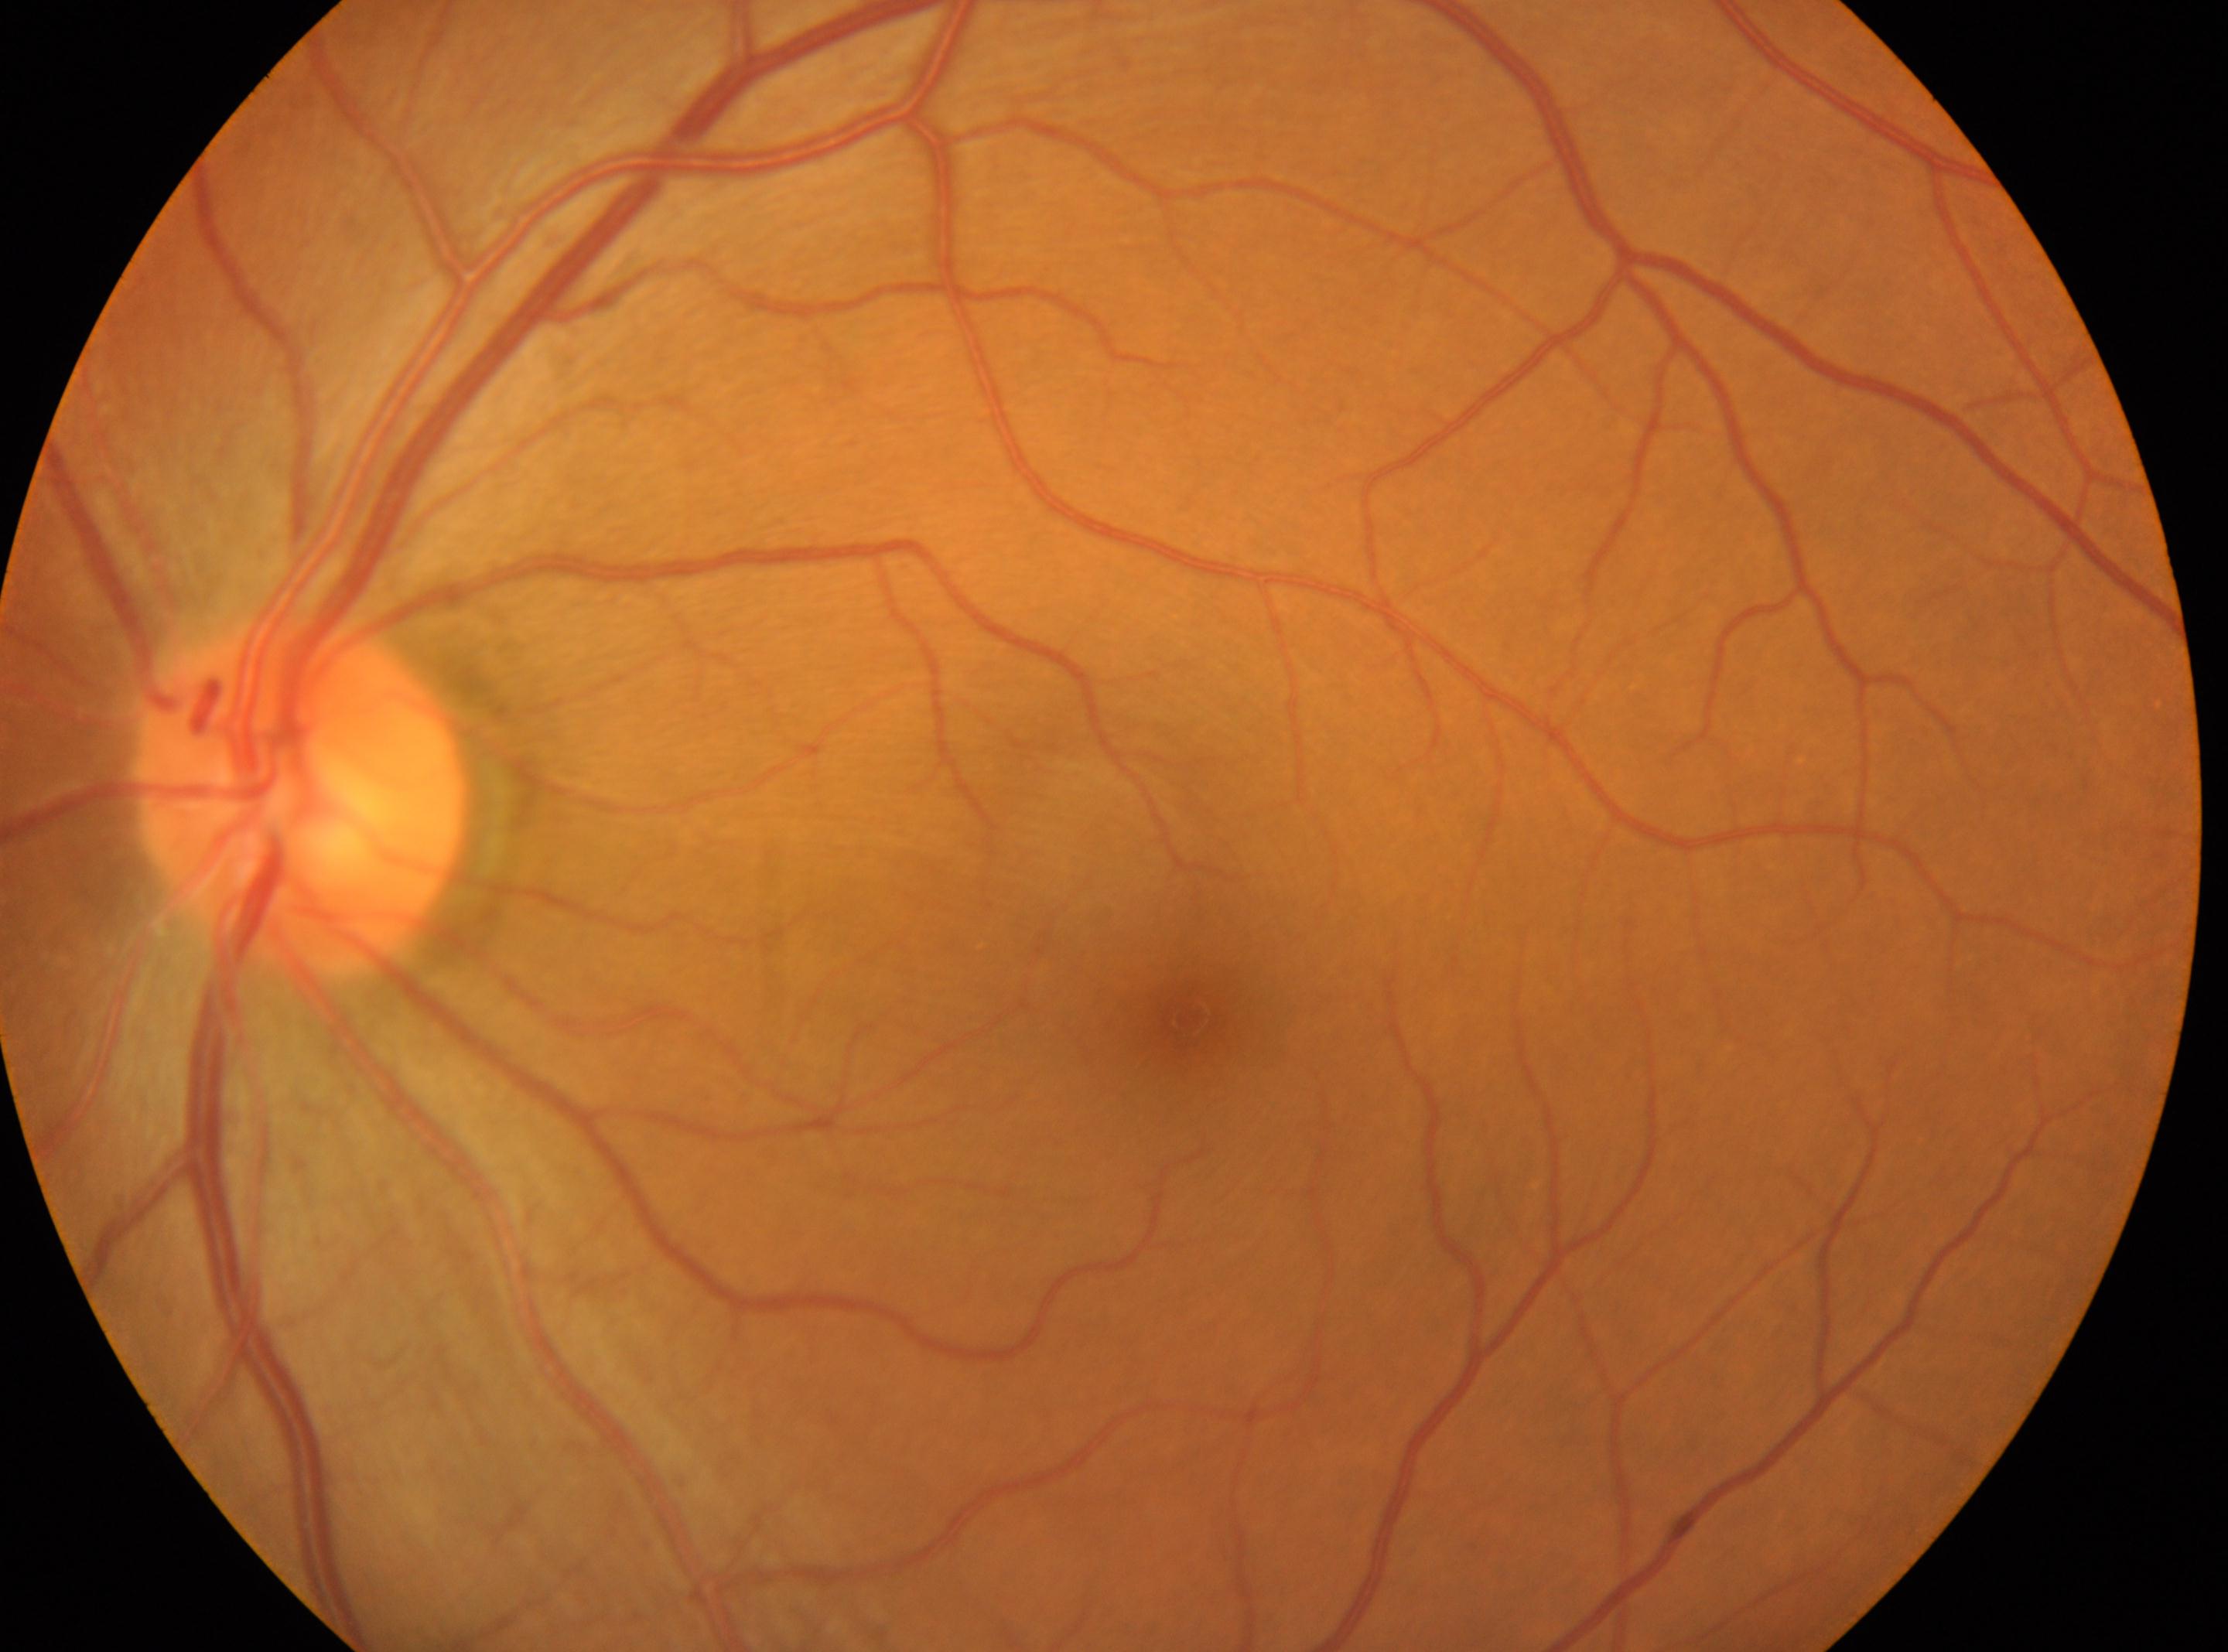
The disc center is at x=298, y=794.
The fovea centralis is at x=1188, y=1018.
No diabetic retinopathy identified.
Retinopathy: 0.
The image shows the OS.